Image size 2352x1568. 45° FOV
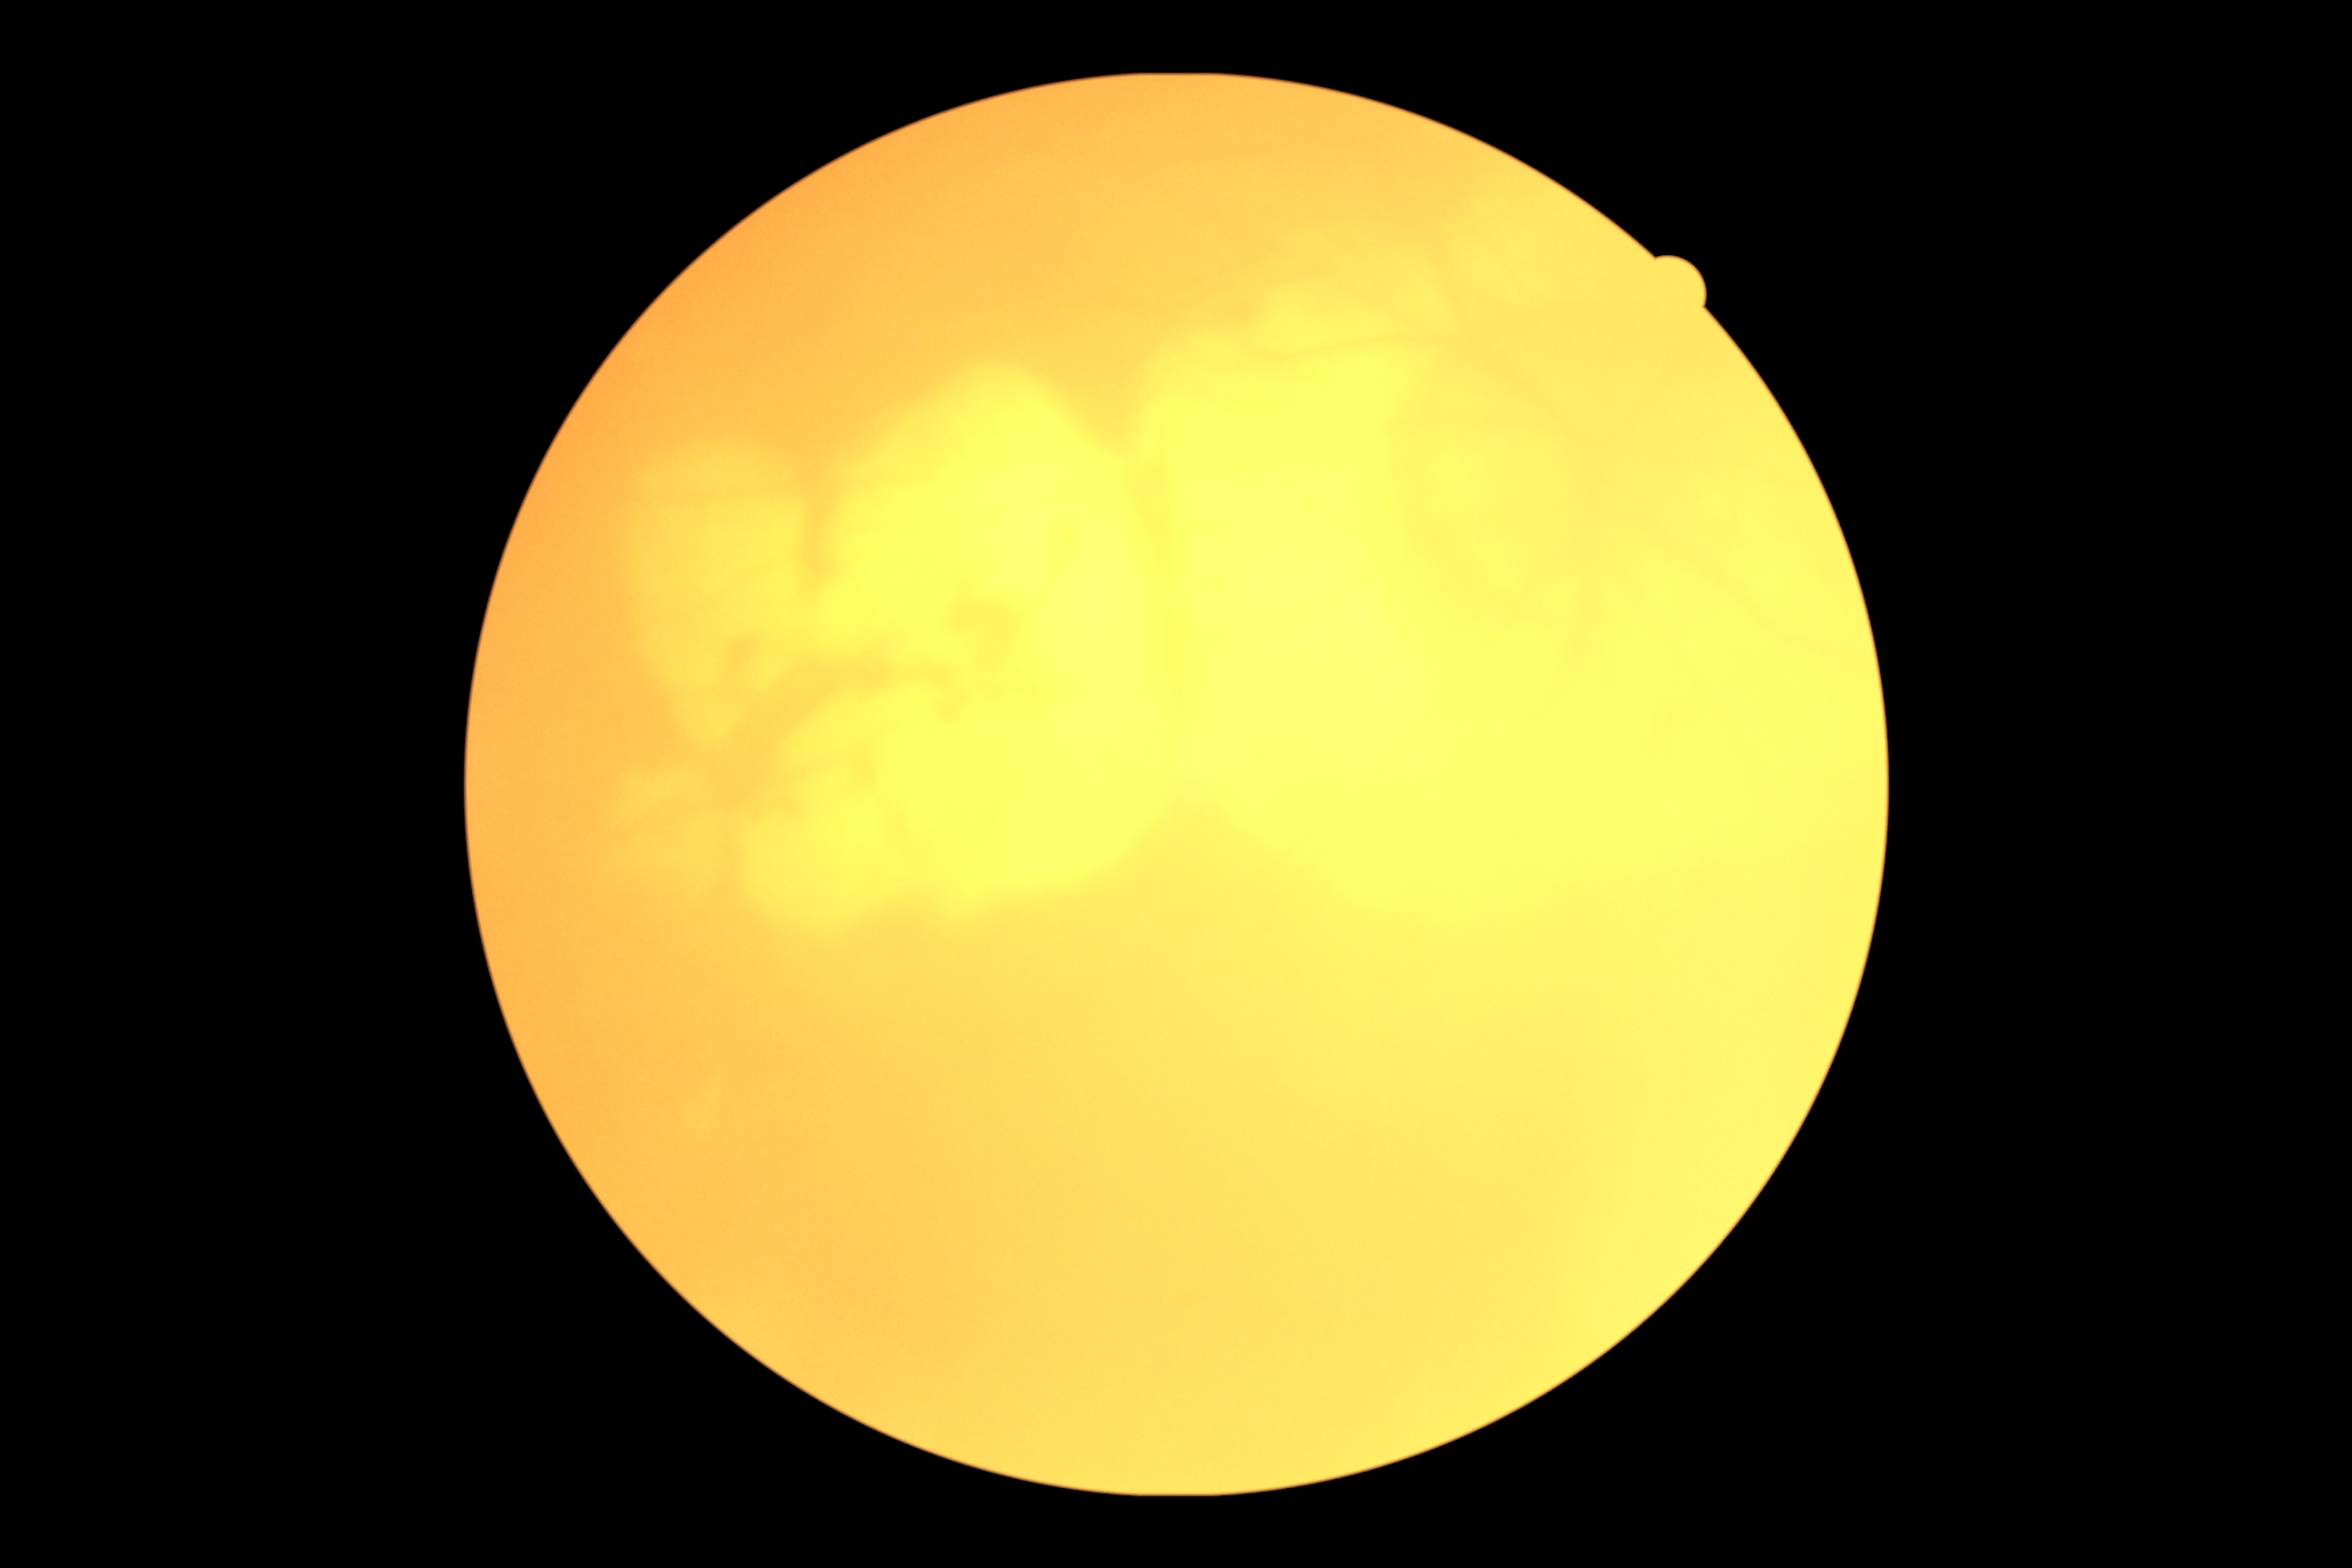

DR severity@ungradable due to poor image quality.